35° field of view before cropping, disc-centered fundus crop, image size 442x442: 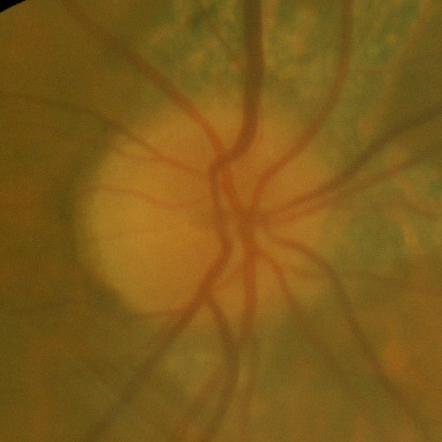
Findings consistent with no signs of glaucoma.